Retinal fundus photograph · 412 x 310 pixels — 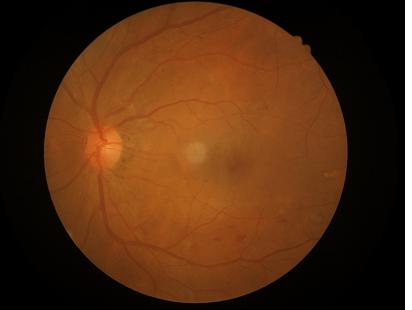

No over- or under-exposure. Overall quality is good and the image is gradable. No noticeable blur.